FOV: 45 degrees:
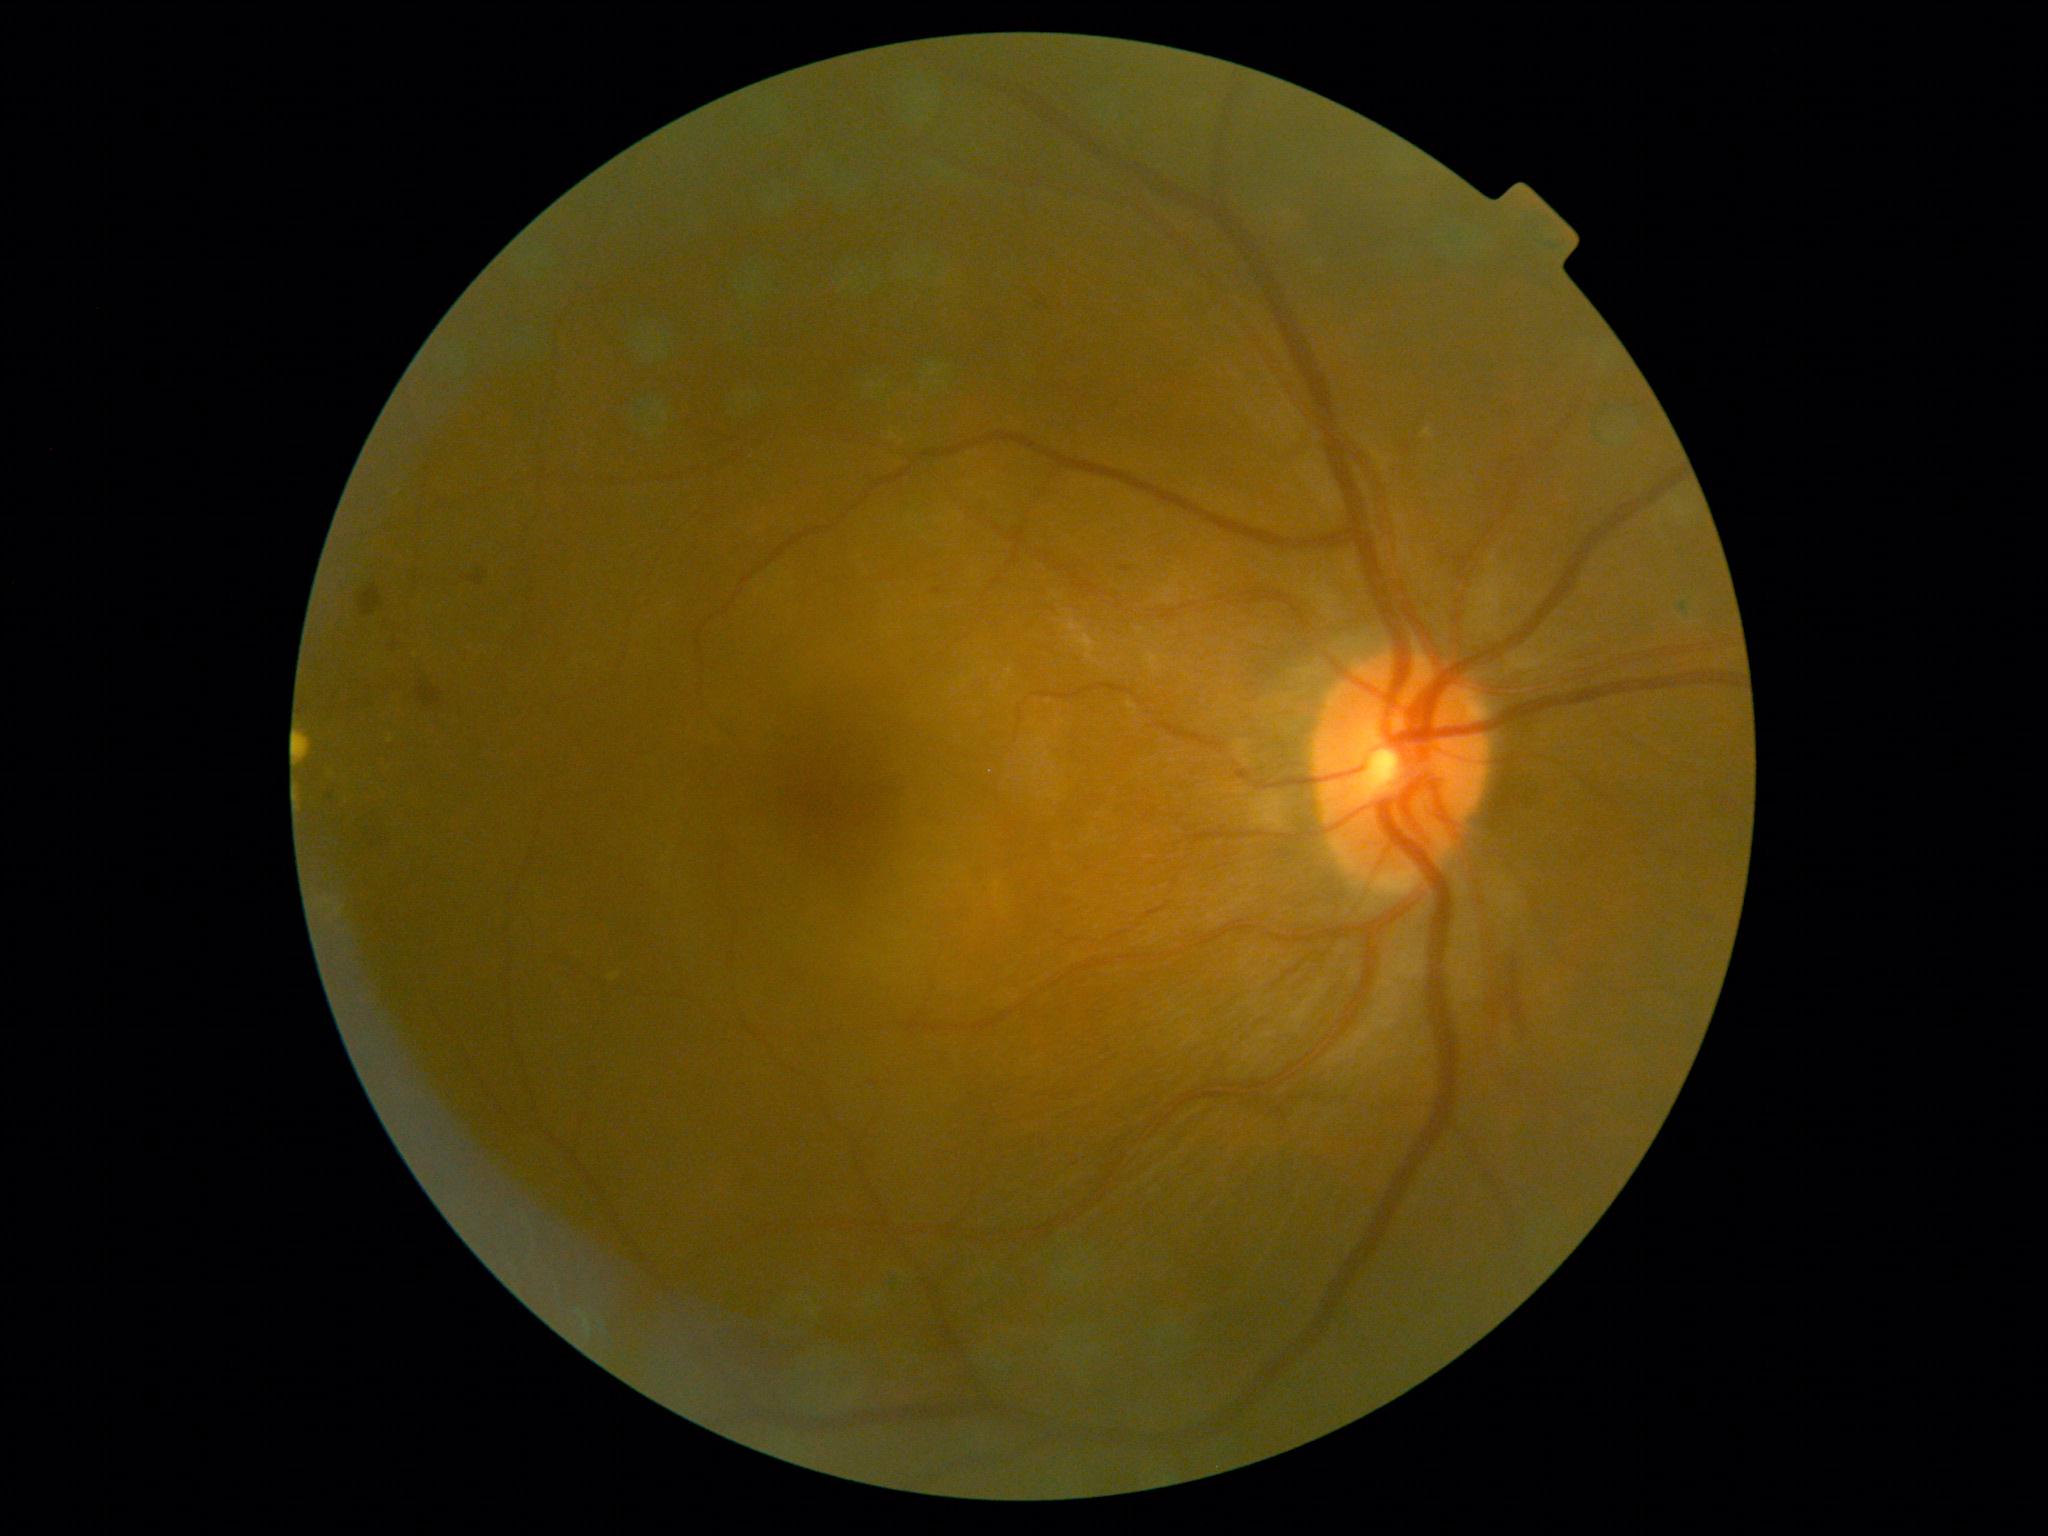 Annotations:
• DR class — non-proliferative diabetic retinopathy
• diabetic retinopathy (DR) — 2/4